Modified Davis classification:
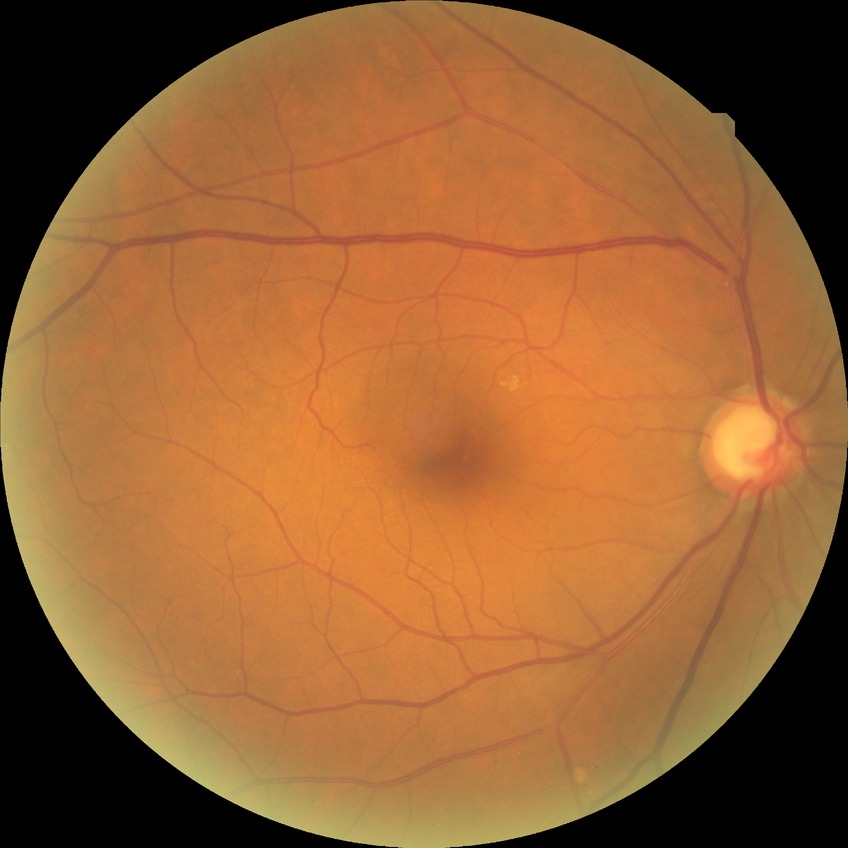

diabetic retinopathy (DR)=NDR (no diabetic retinopathy).